45° FOV · graded on the modified Davis scale · 848 by 848 pixels · NIDEK AFC-230 · no pharmacologic dilation · retinal fundus photograph — 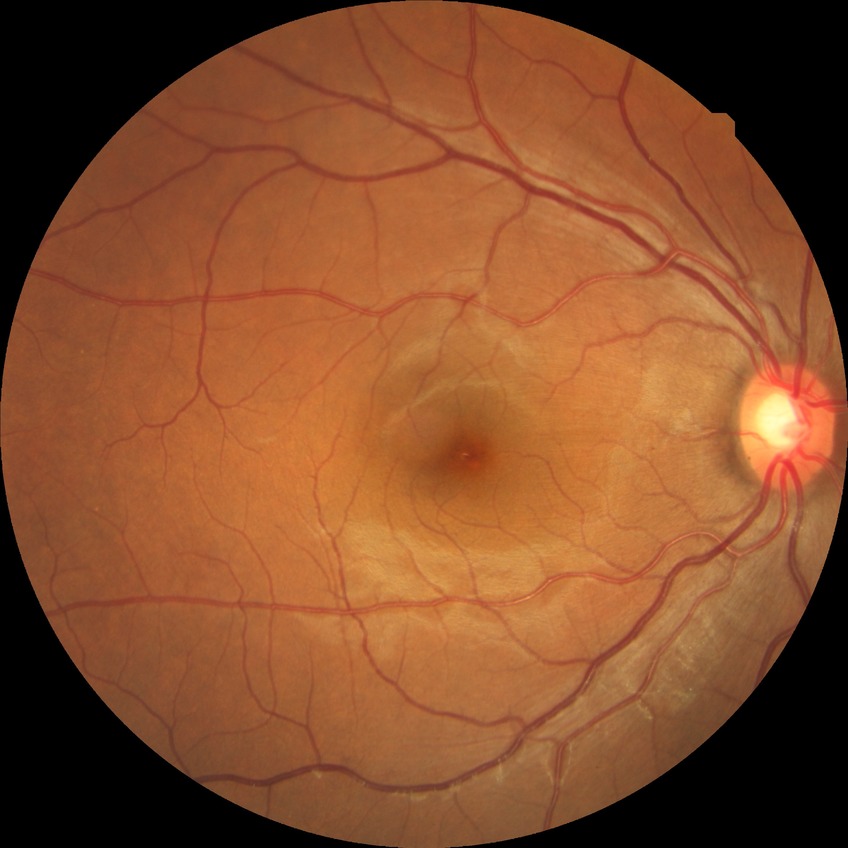

Diabetic retinopathy (DR) is no diabetic retinopathy (NDR).